Optic nerve head crop · fundus photo · non-mydriatic acquisition.
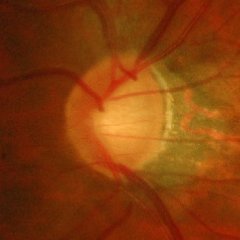

Severe glaucomatous damage.